45-degree field of view:
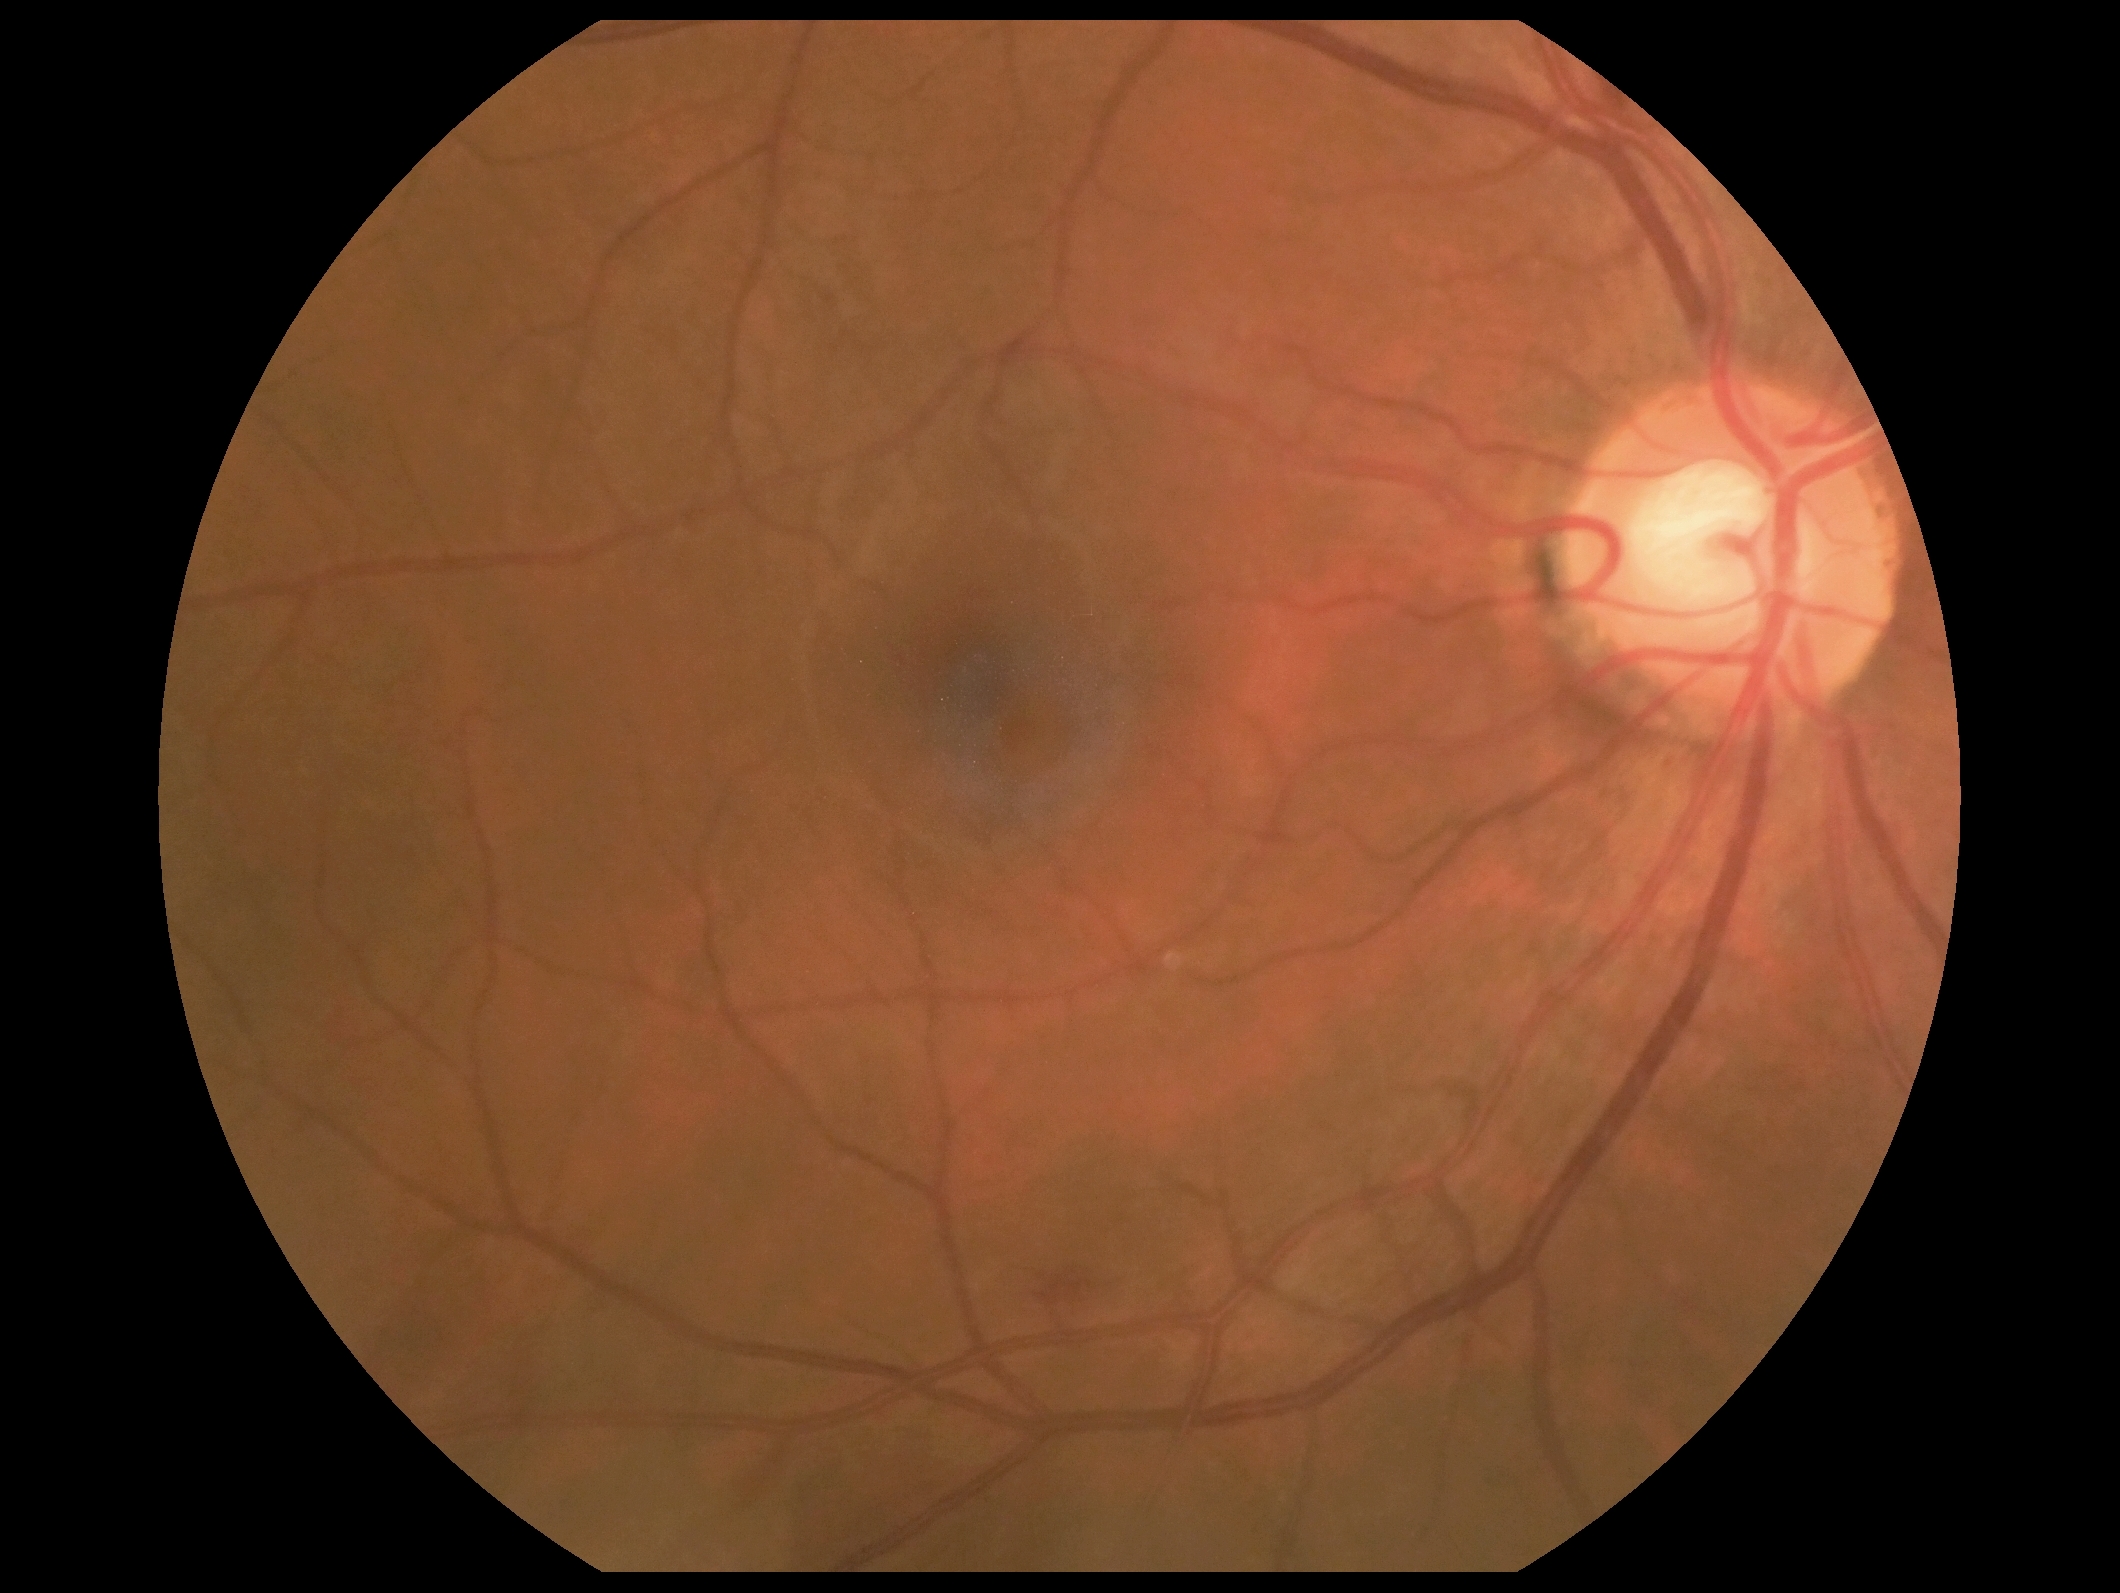

DR: grade 2 (moderate NPDR) — more than just microaneurysms but less than severe NPDR.
Disease class: non-proliferative diabetic retinopathy.